1971 x 1876 pixels, color fundus photograph
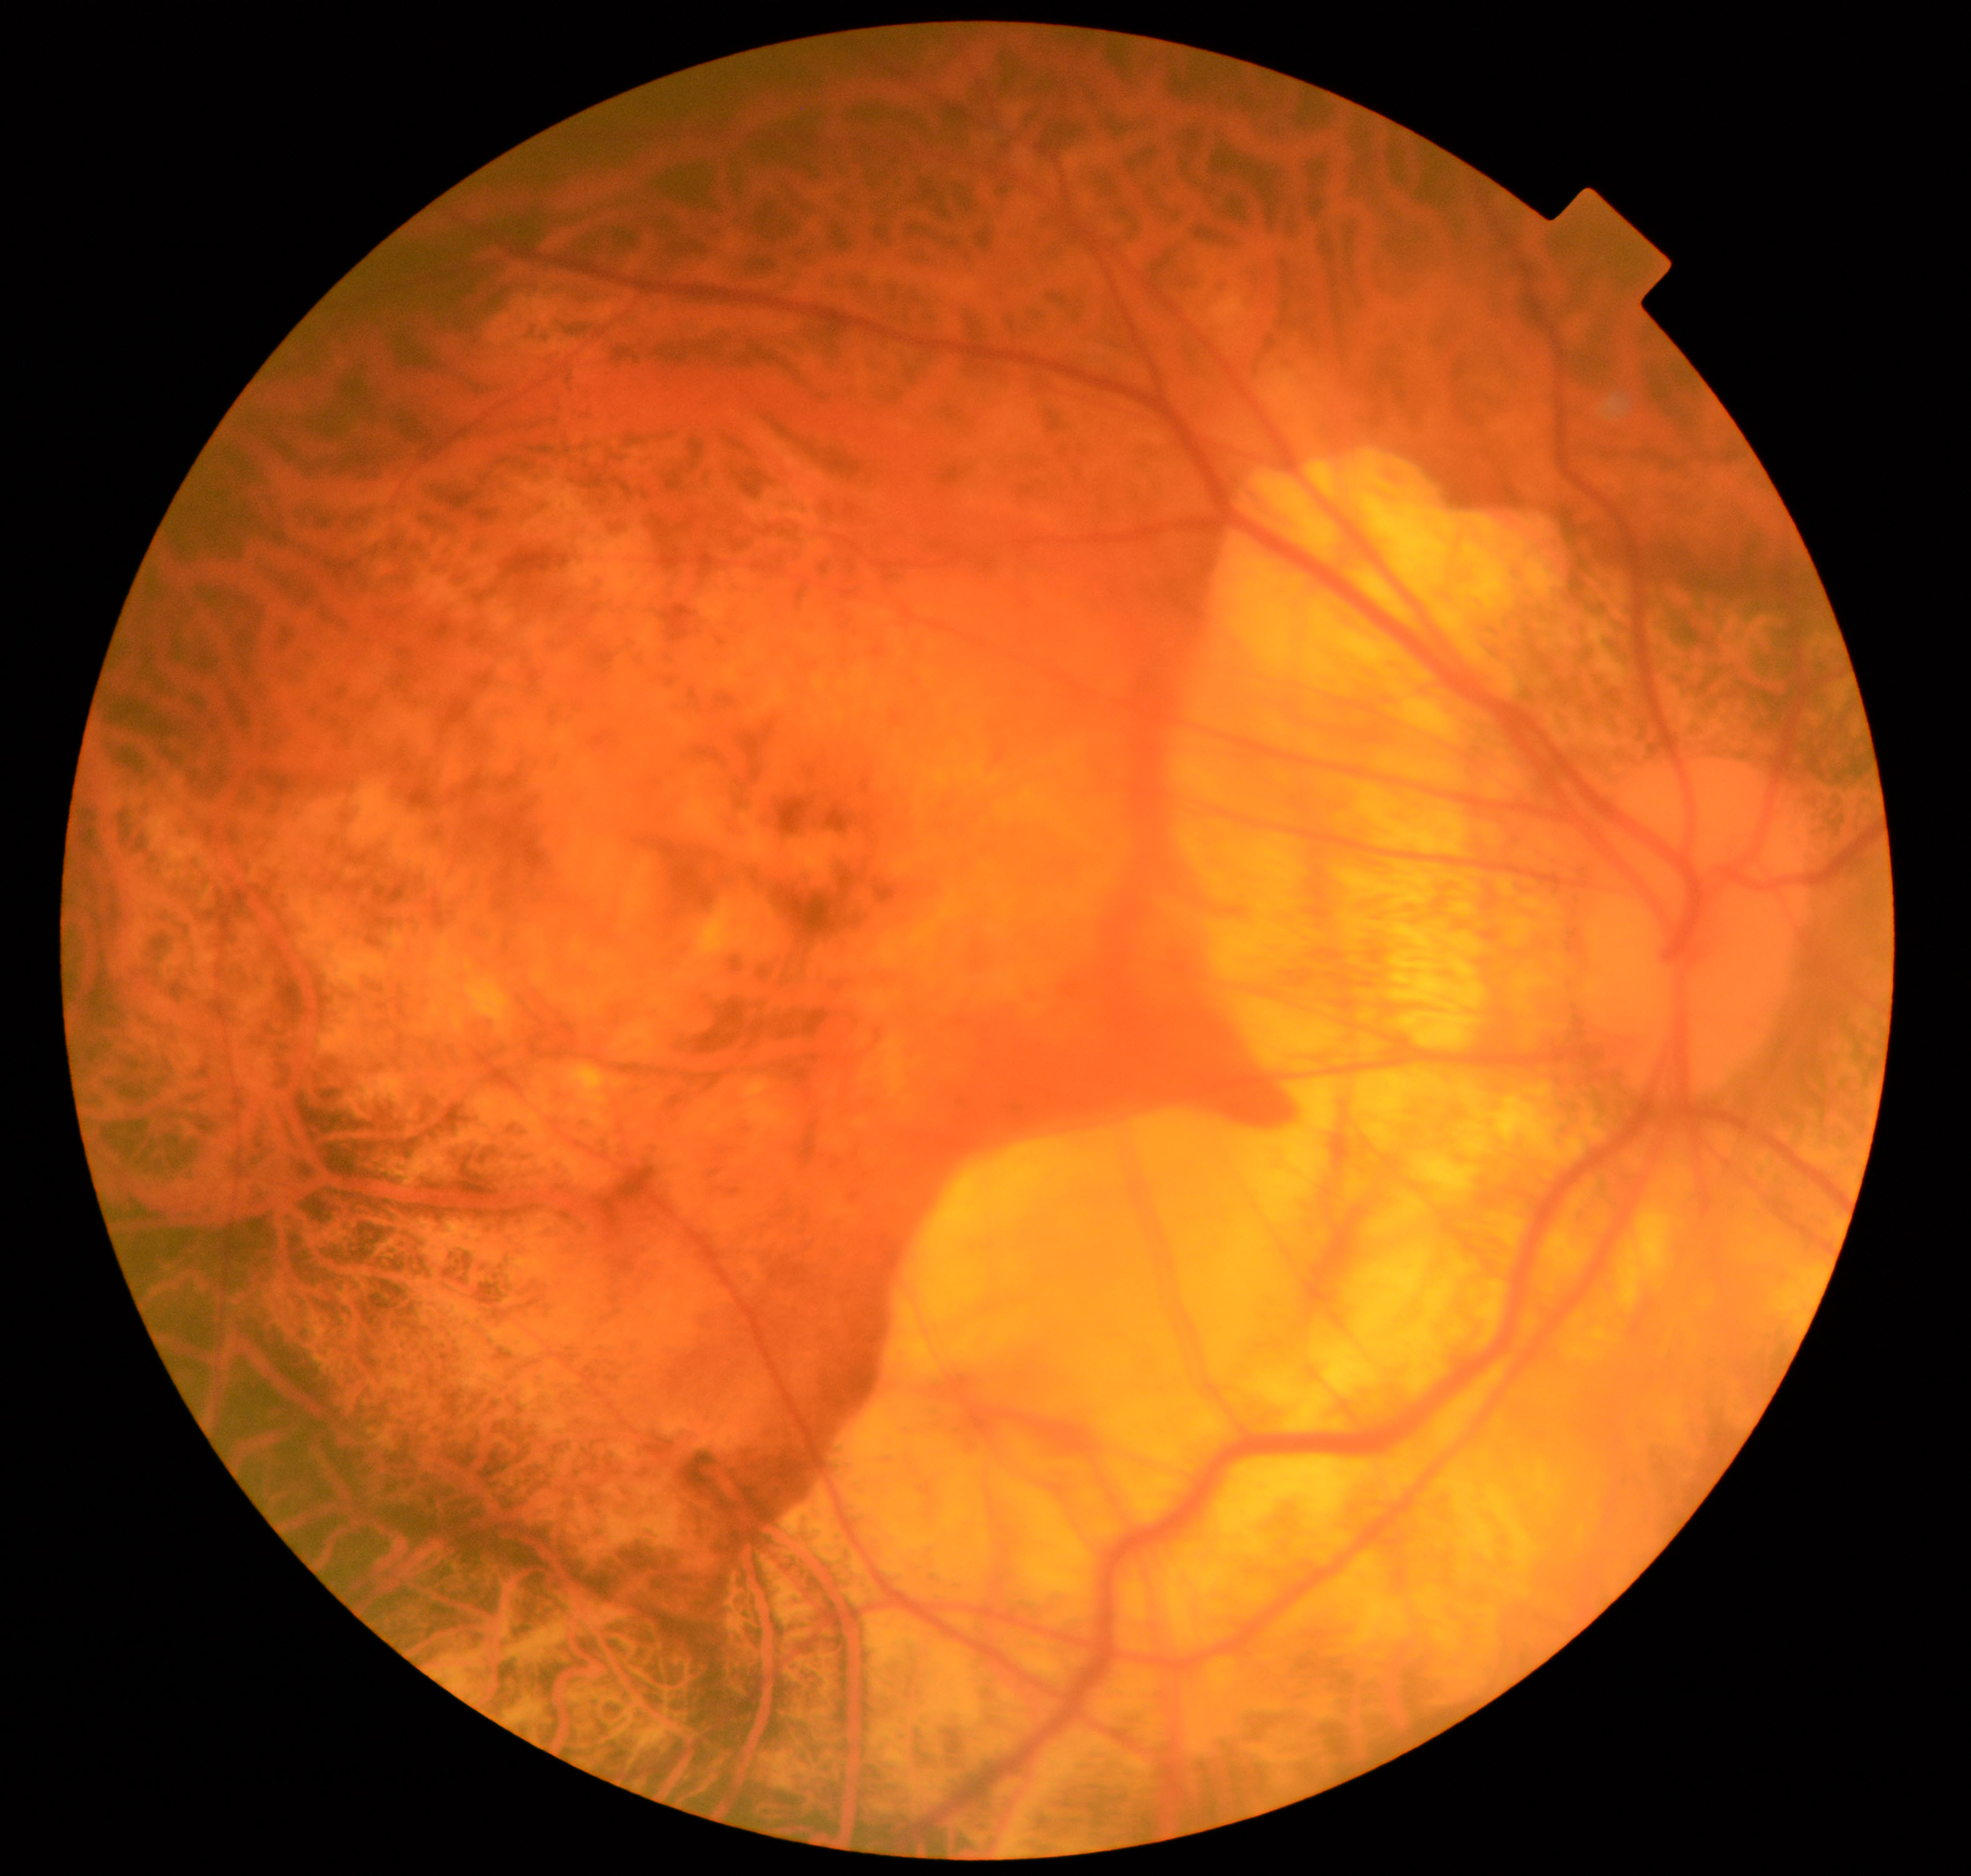
The image shows pathological myopia.